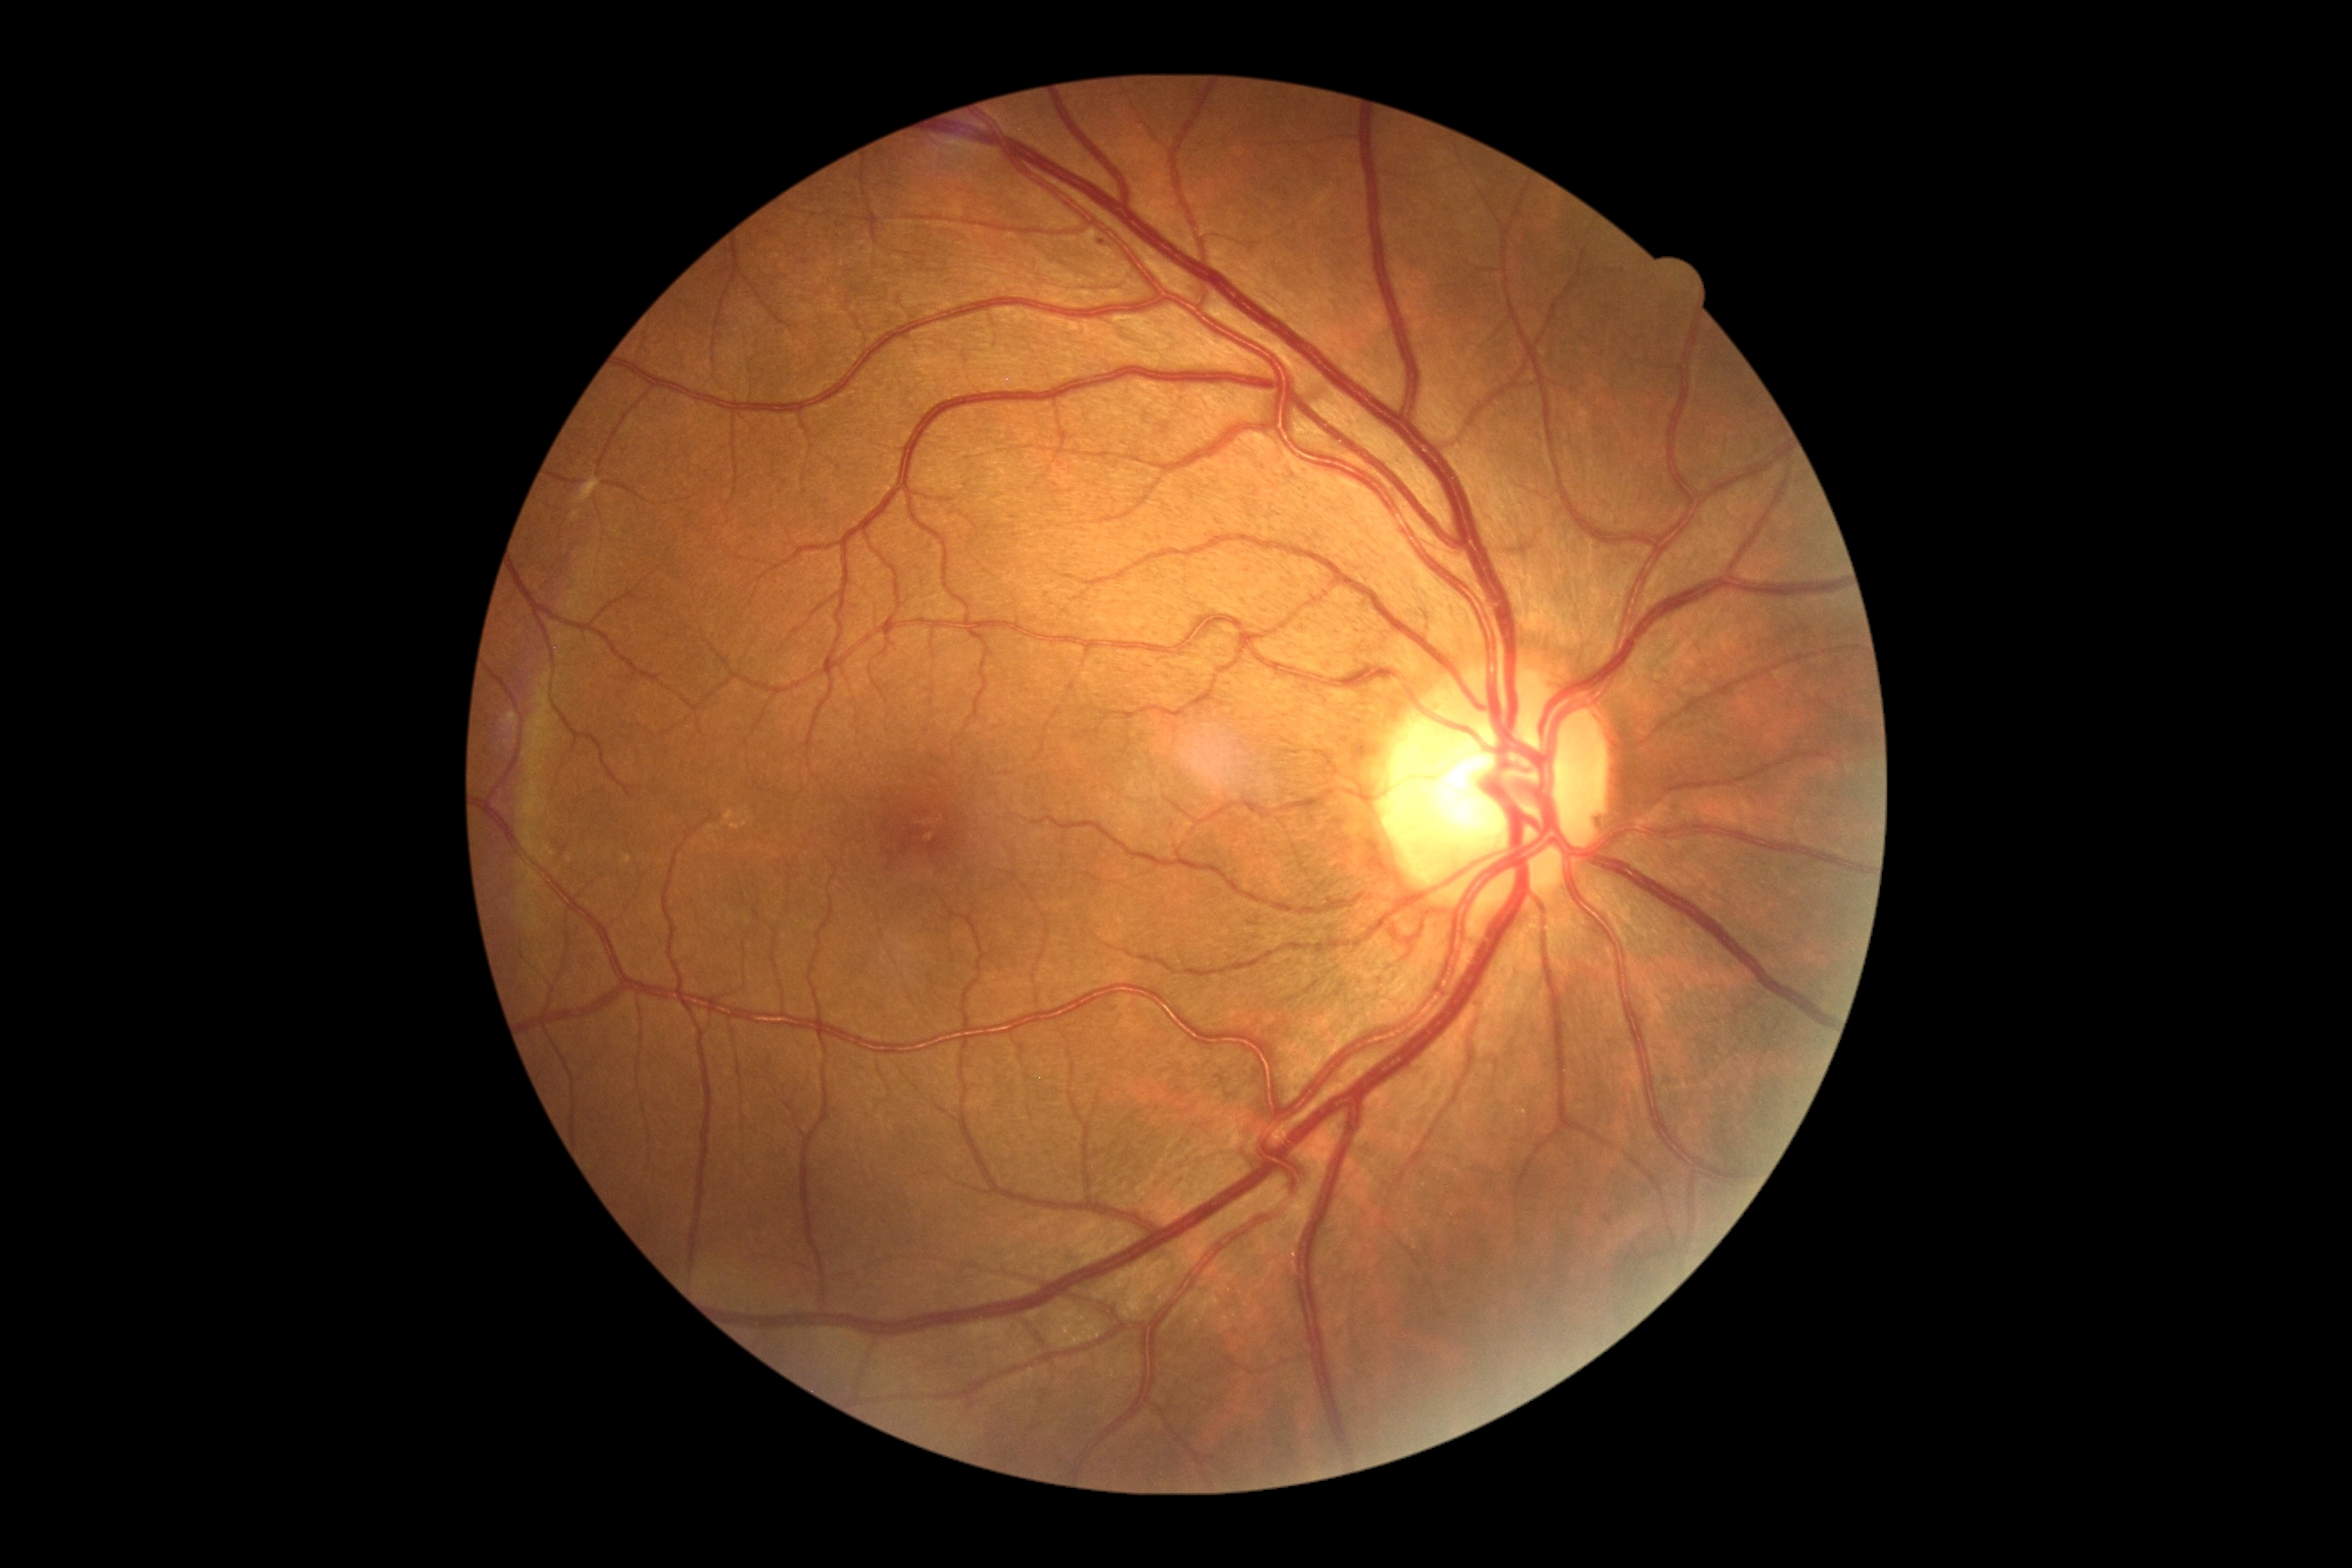 Diabetic retinopathy severity is 1/4.